CFP.
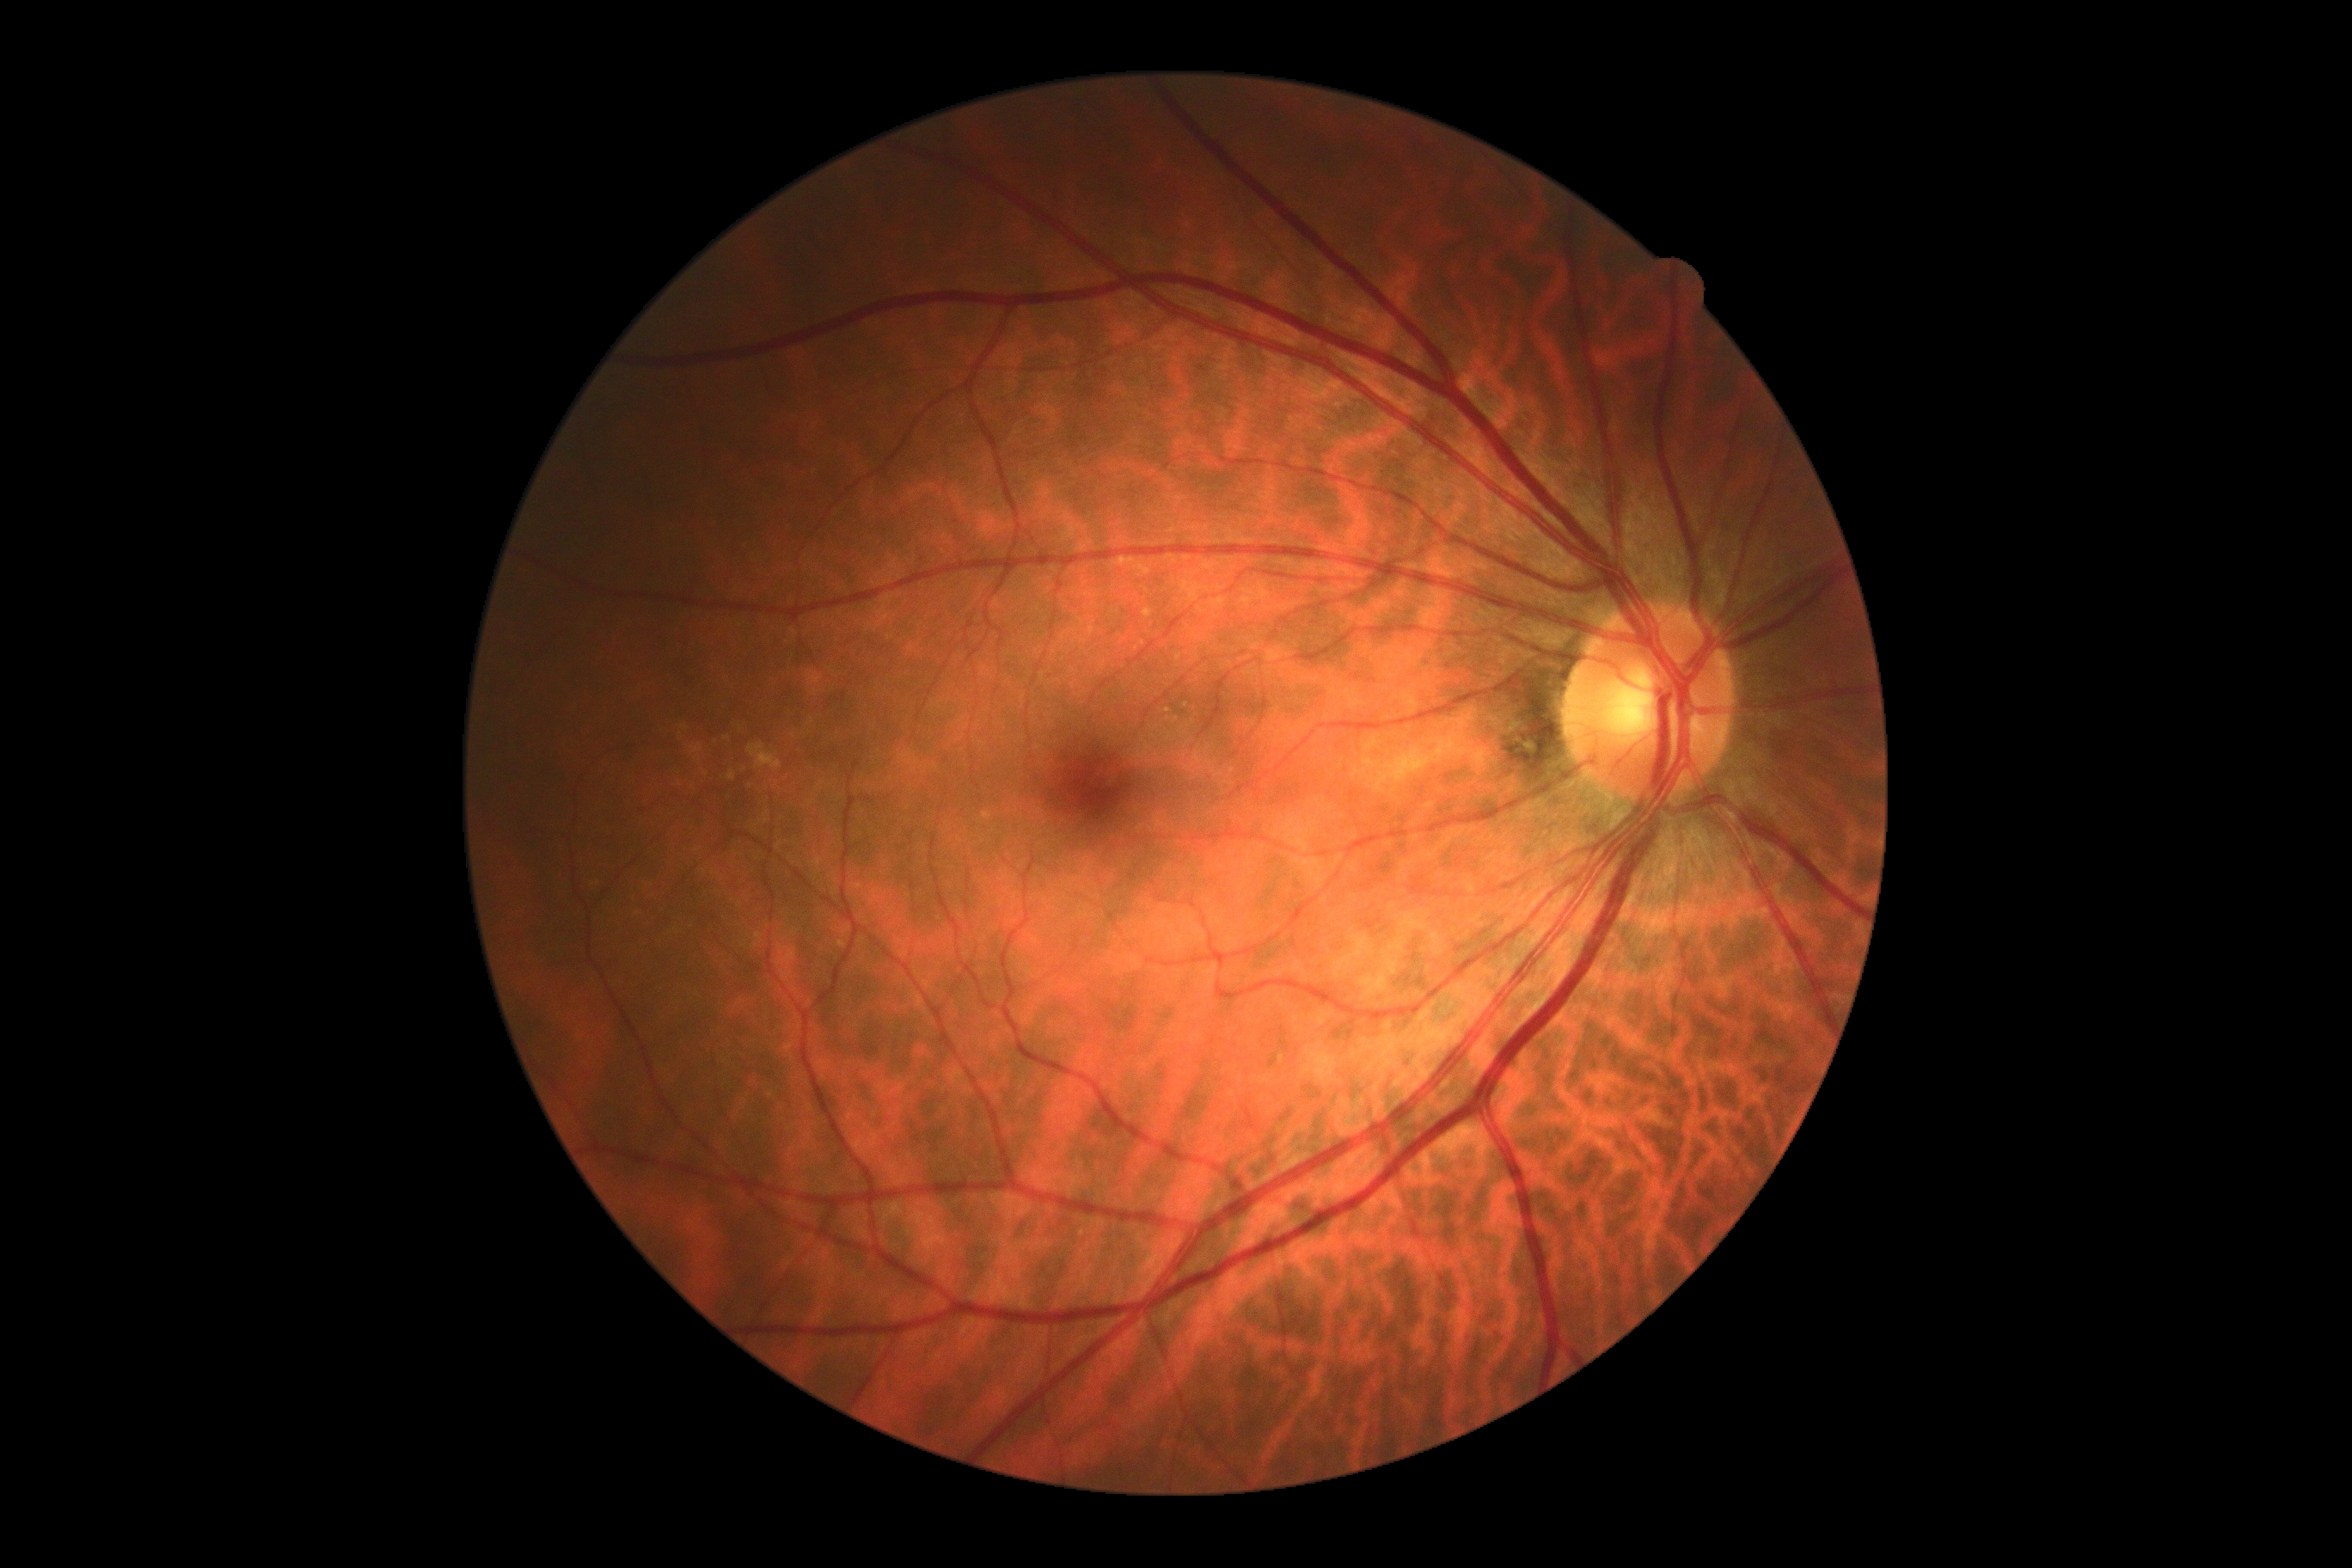

Diabetic retinopathy (DR): 0/4.